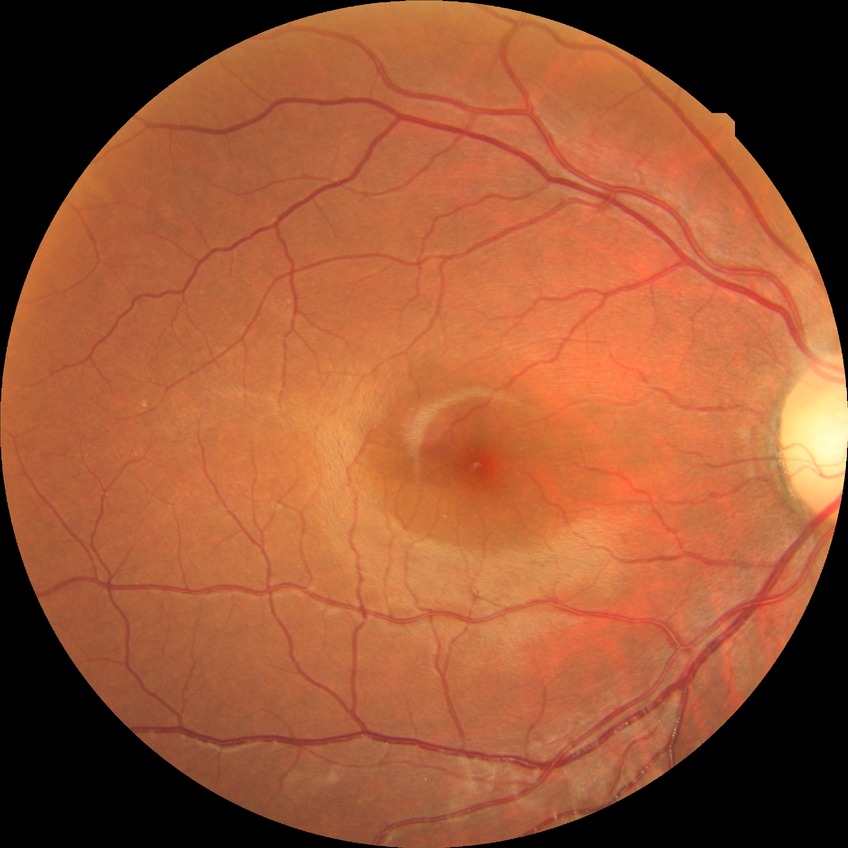 No signs of diabetic retinopathy.
Davis DR grade is NDR.